Captured with the Phoenix ICON (100° field of view). Wide-field fundus photograph from neonatal ROP screening.
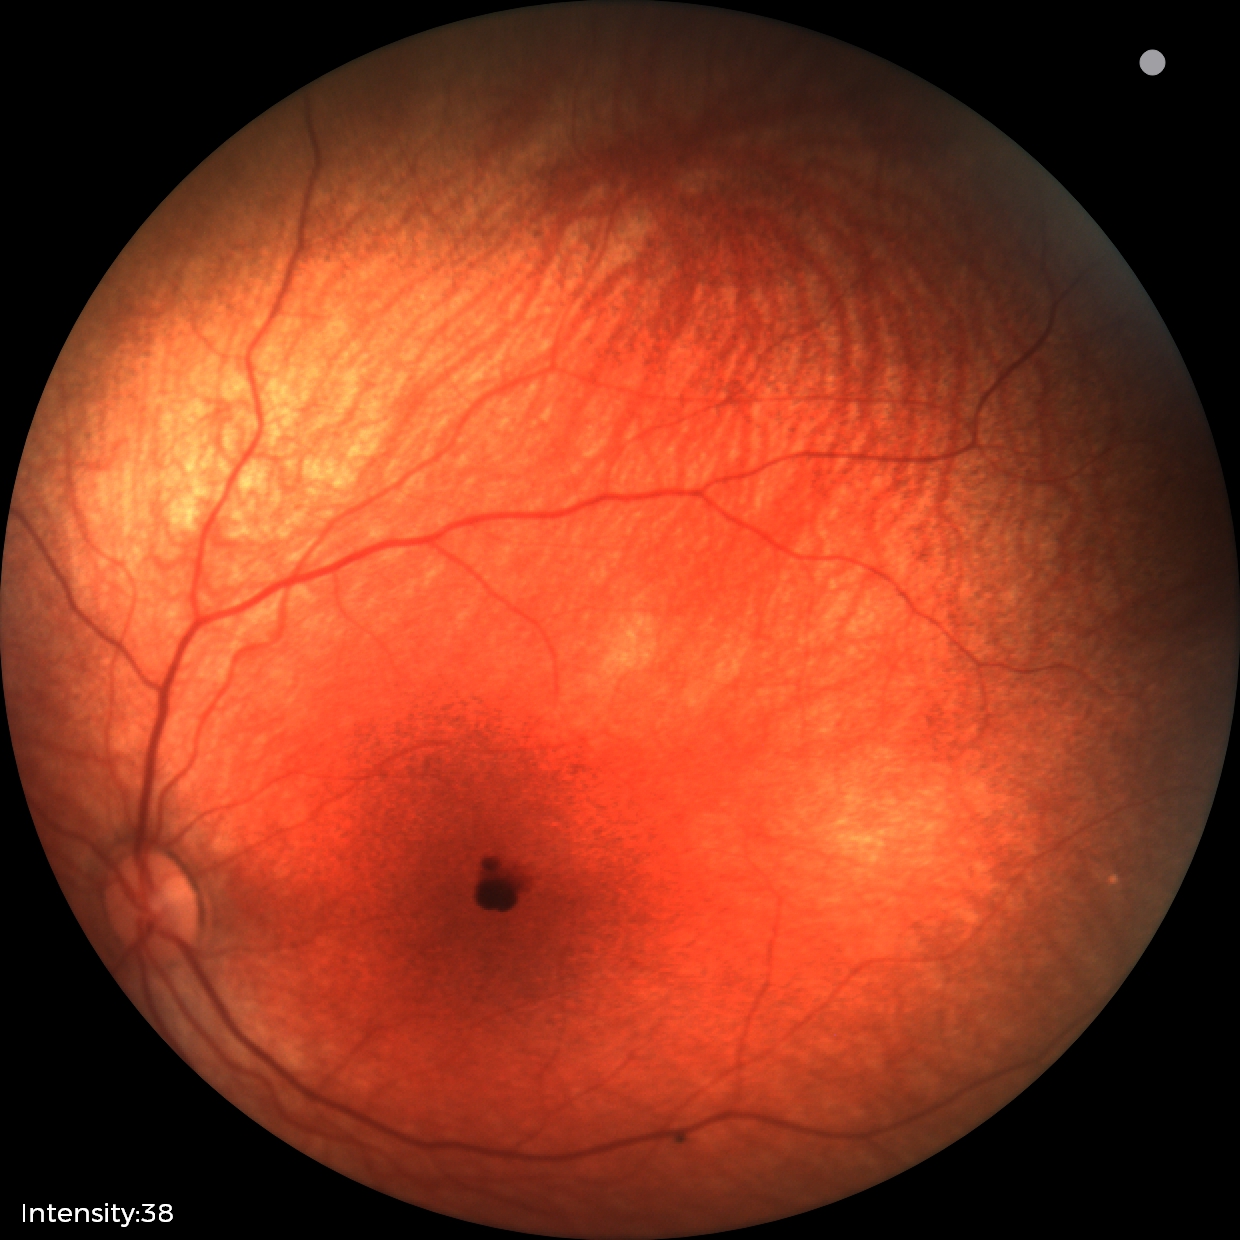 Screening series with retinal hemorrhages.